CFP:
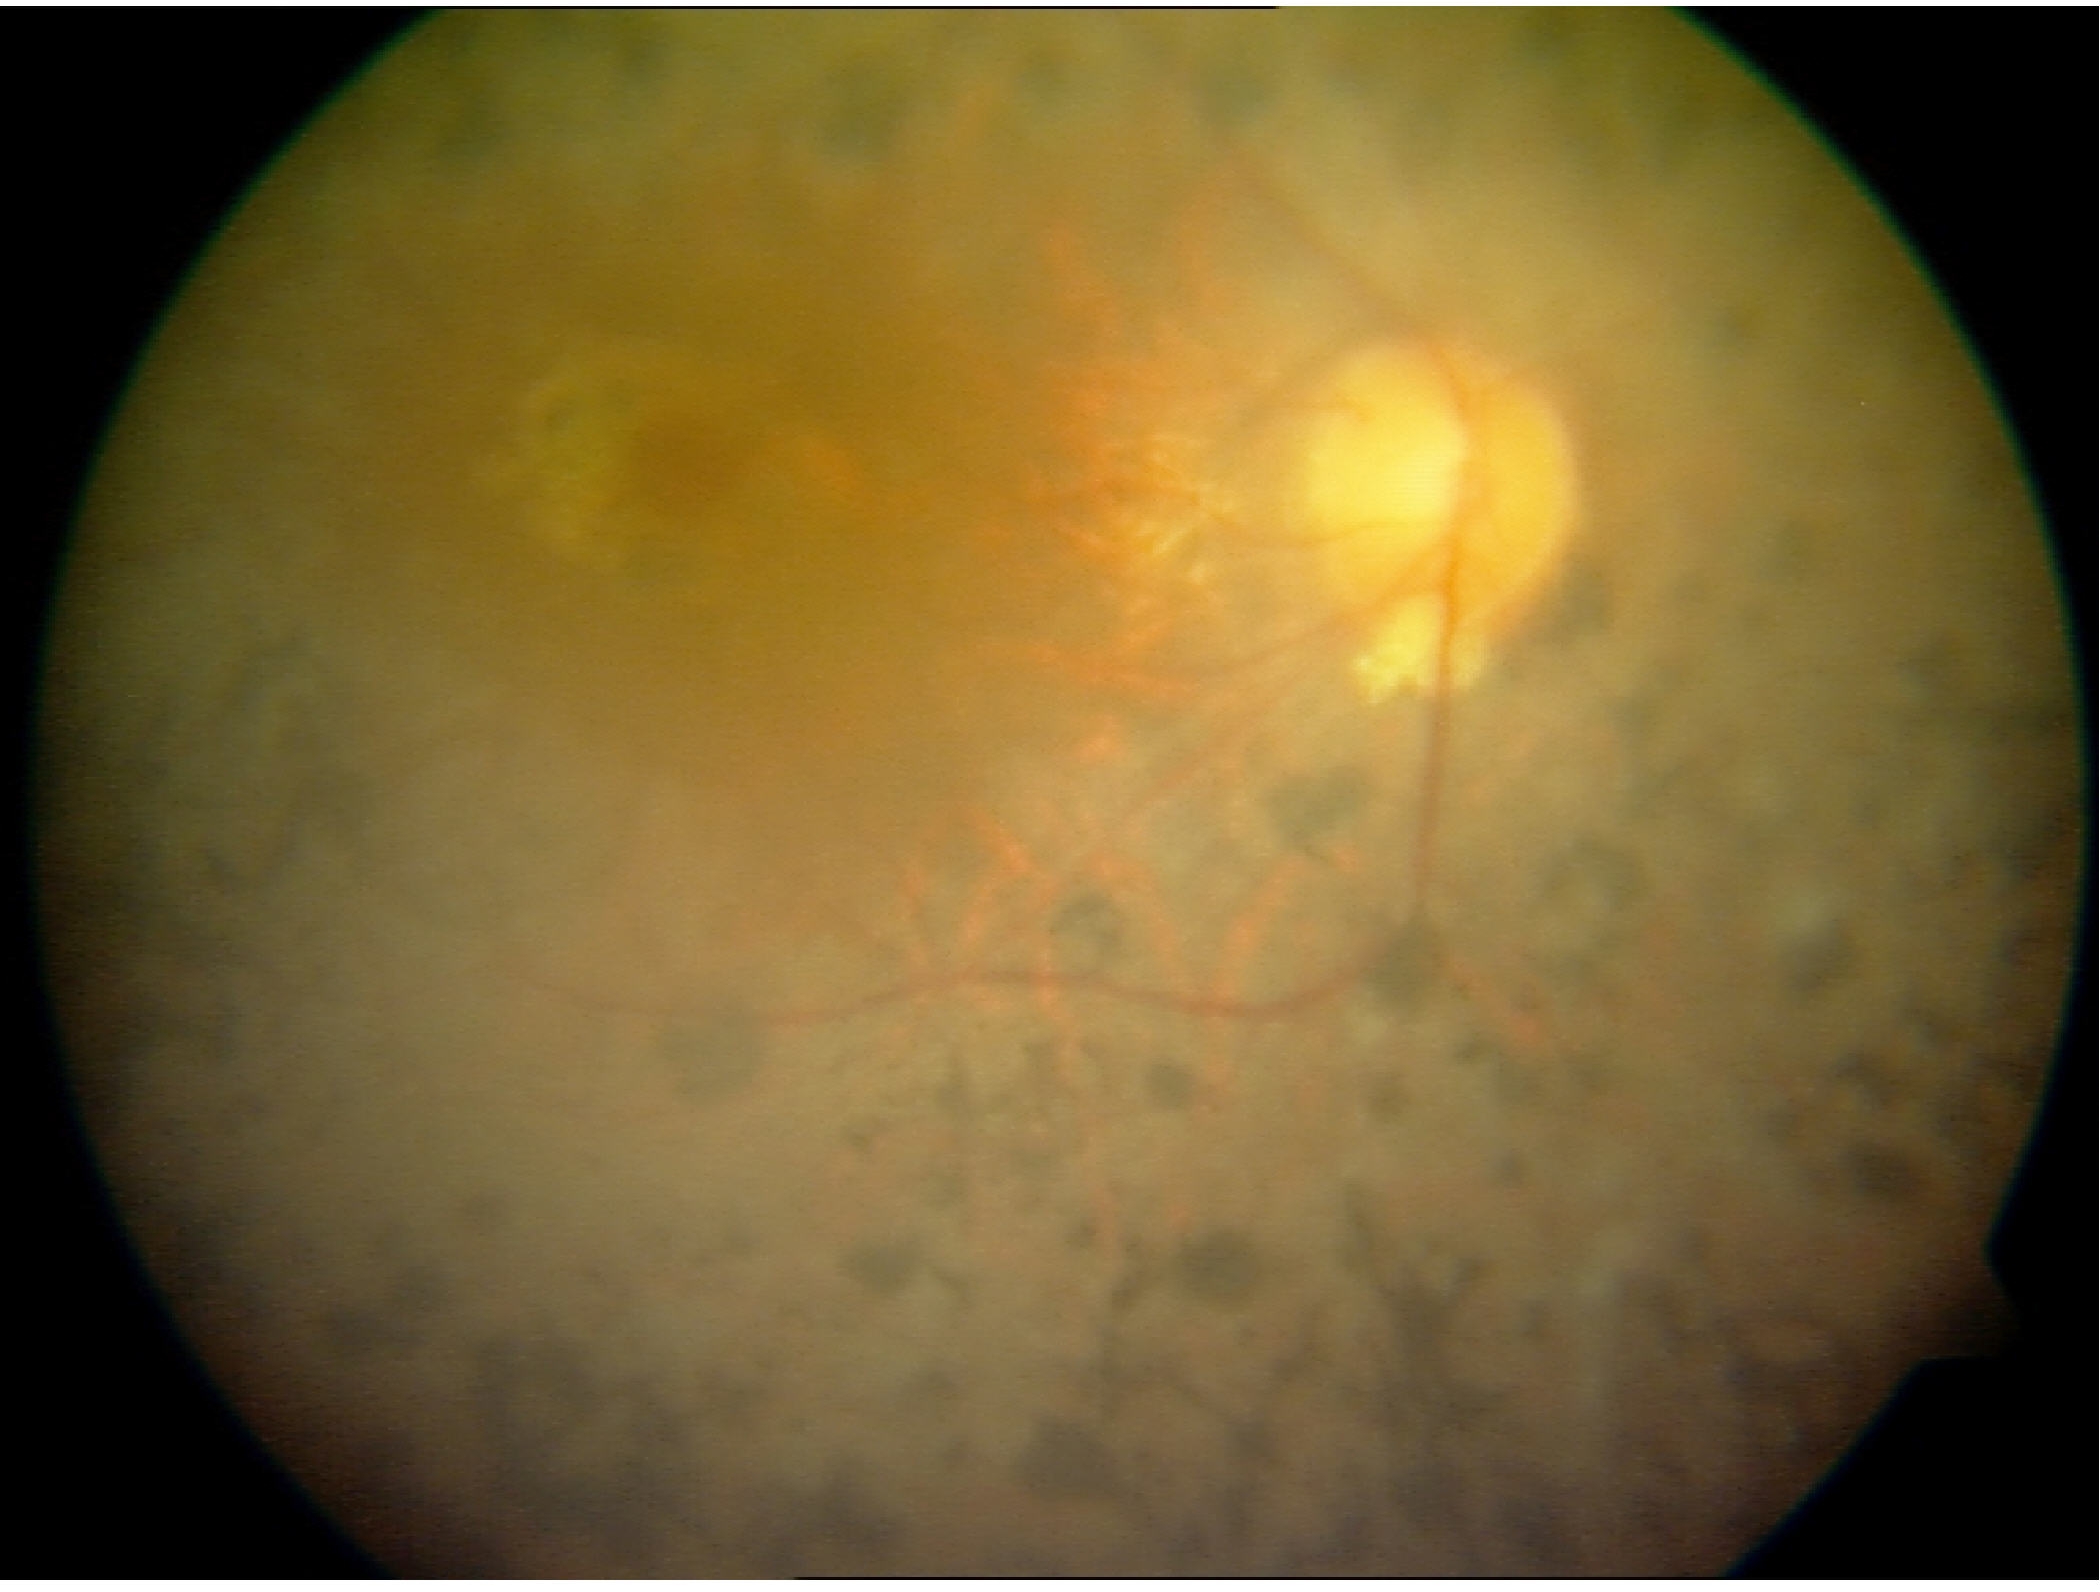
Findings: retinitis pigmentosa.